Phoenix ICON wide-field infant fundus image; 100° field of view (Phoenix ICON)
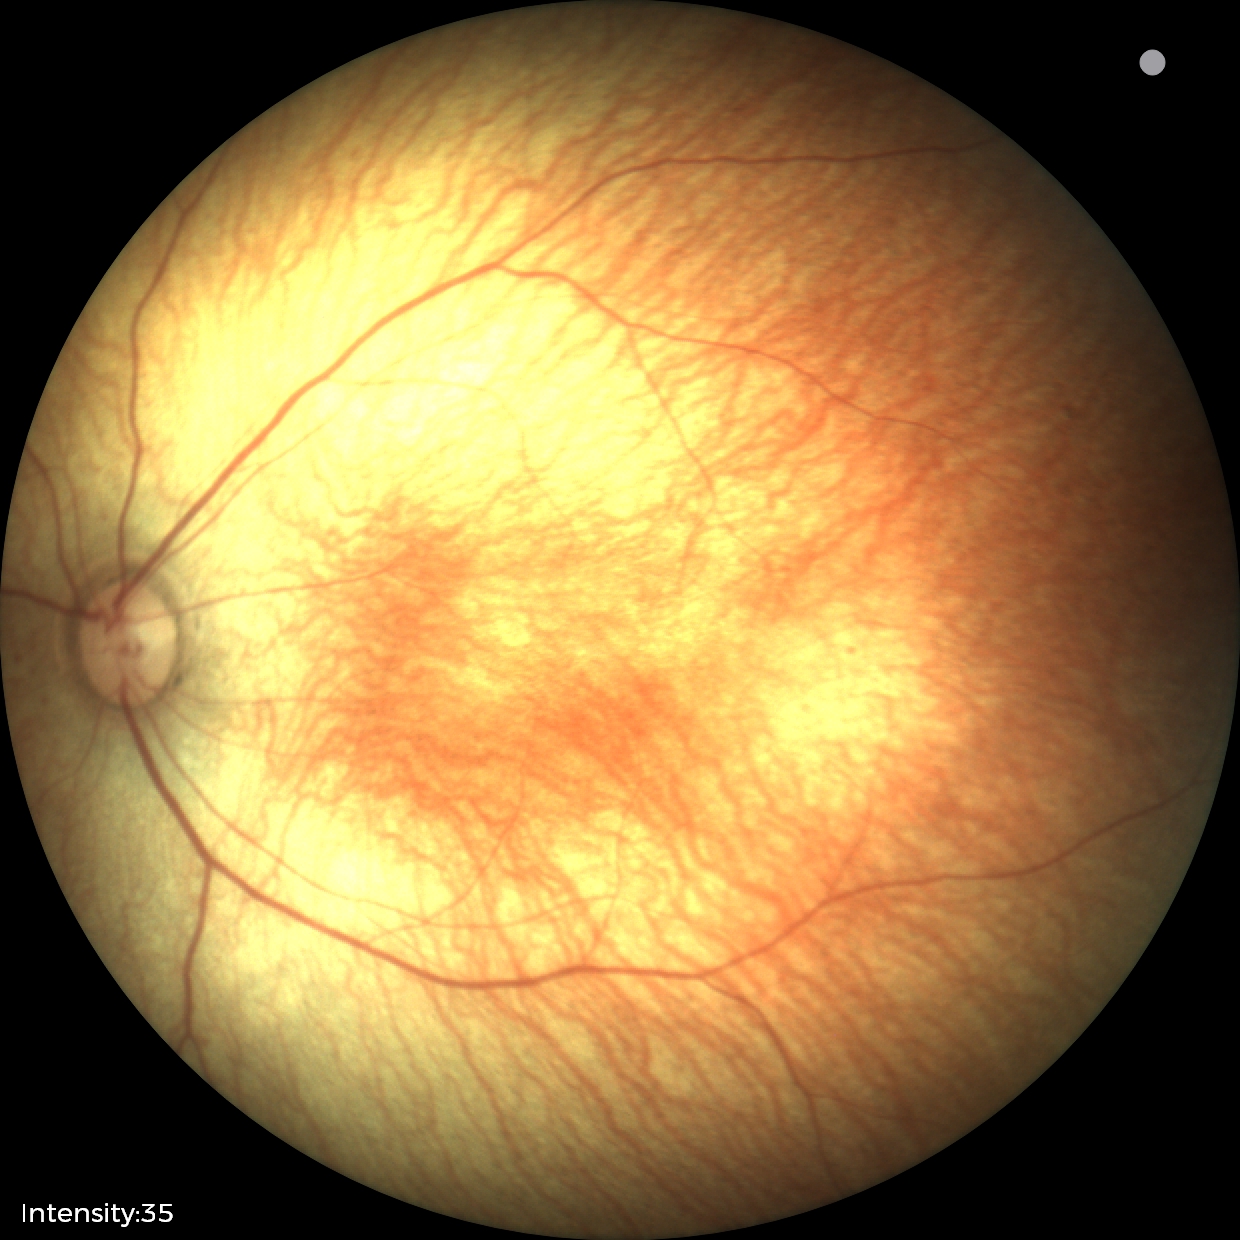 Screening examination diagnosed as physiological.